Davis DR grading: 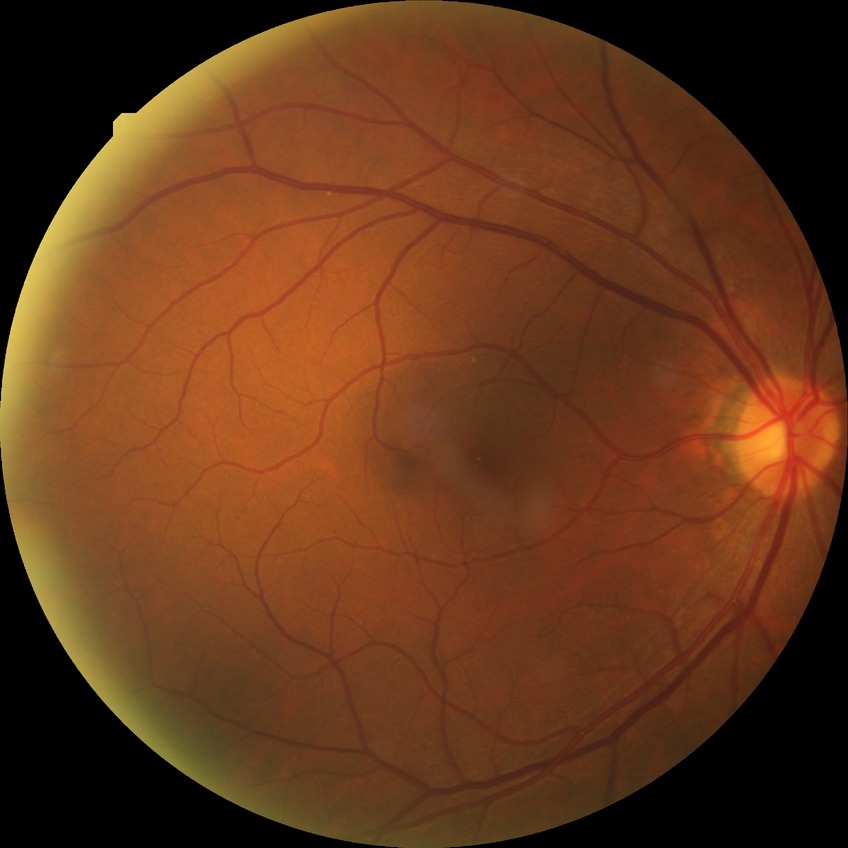

davis_grade: NDR (no diabetic retinopathy)